Acquired with a Nidek AFC-330; color fundus photograph: 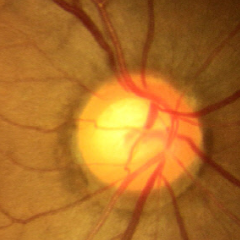
Glaucoma stage = no glaucomatous optic neuropathy.